CFP:
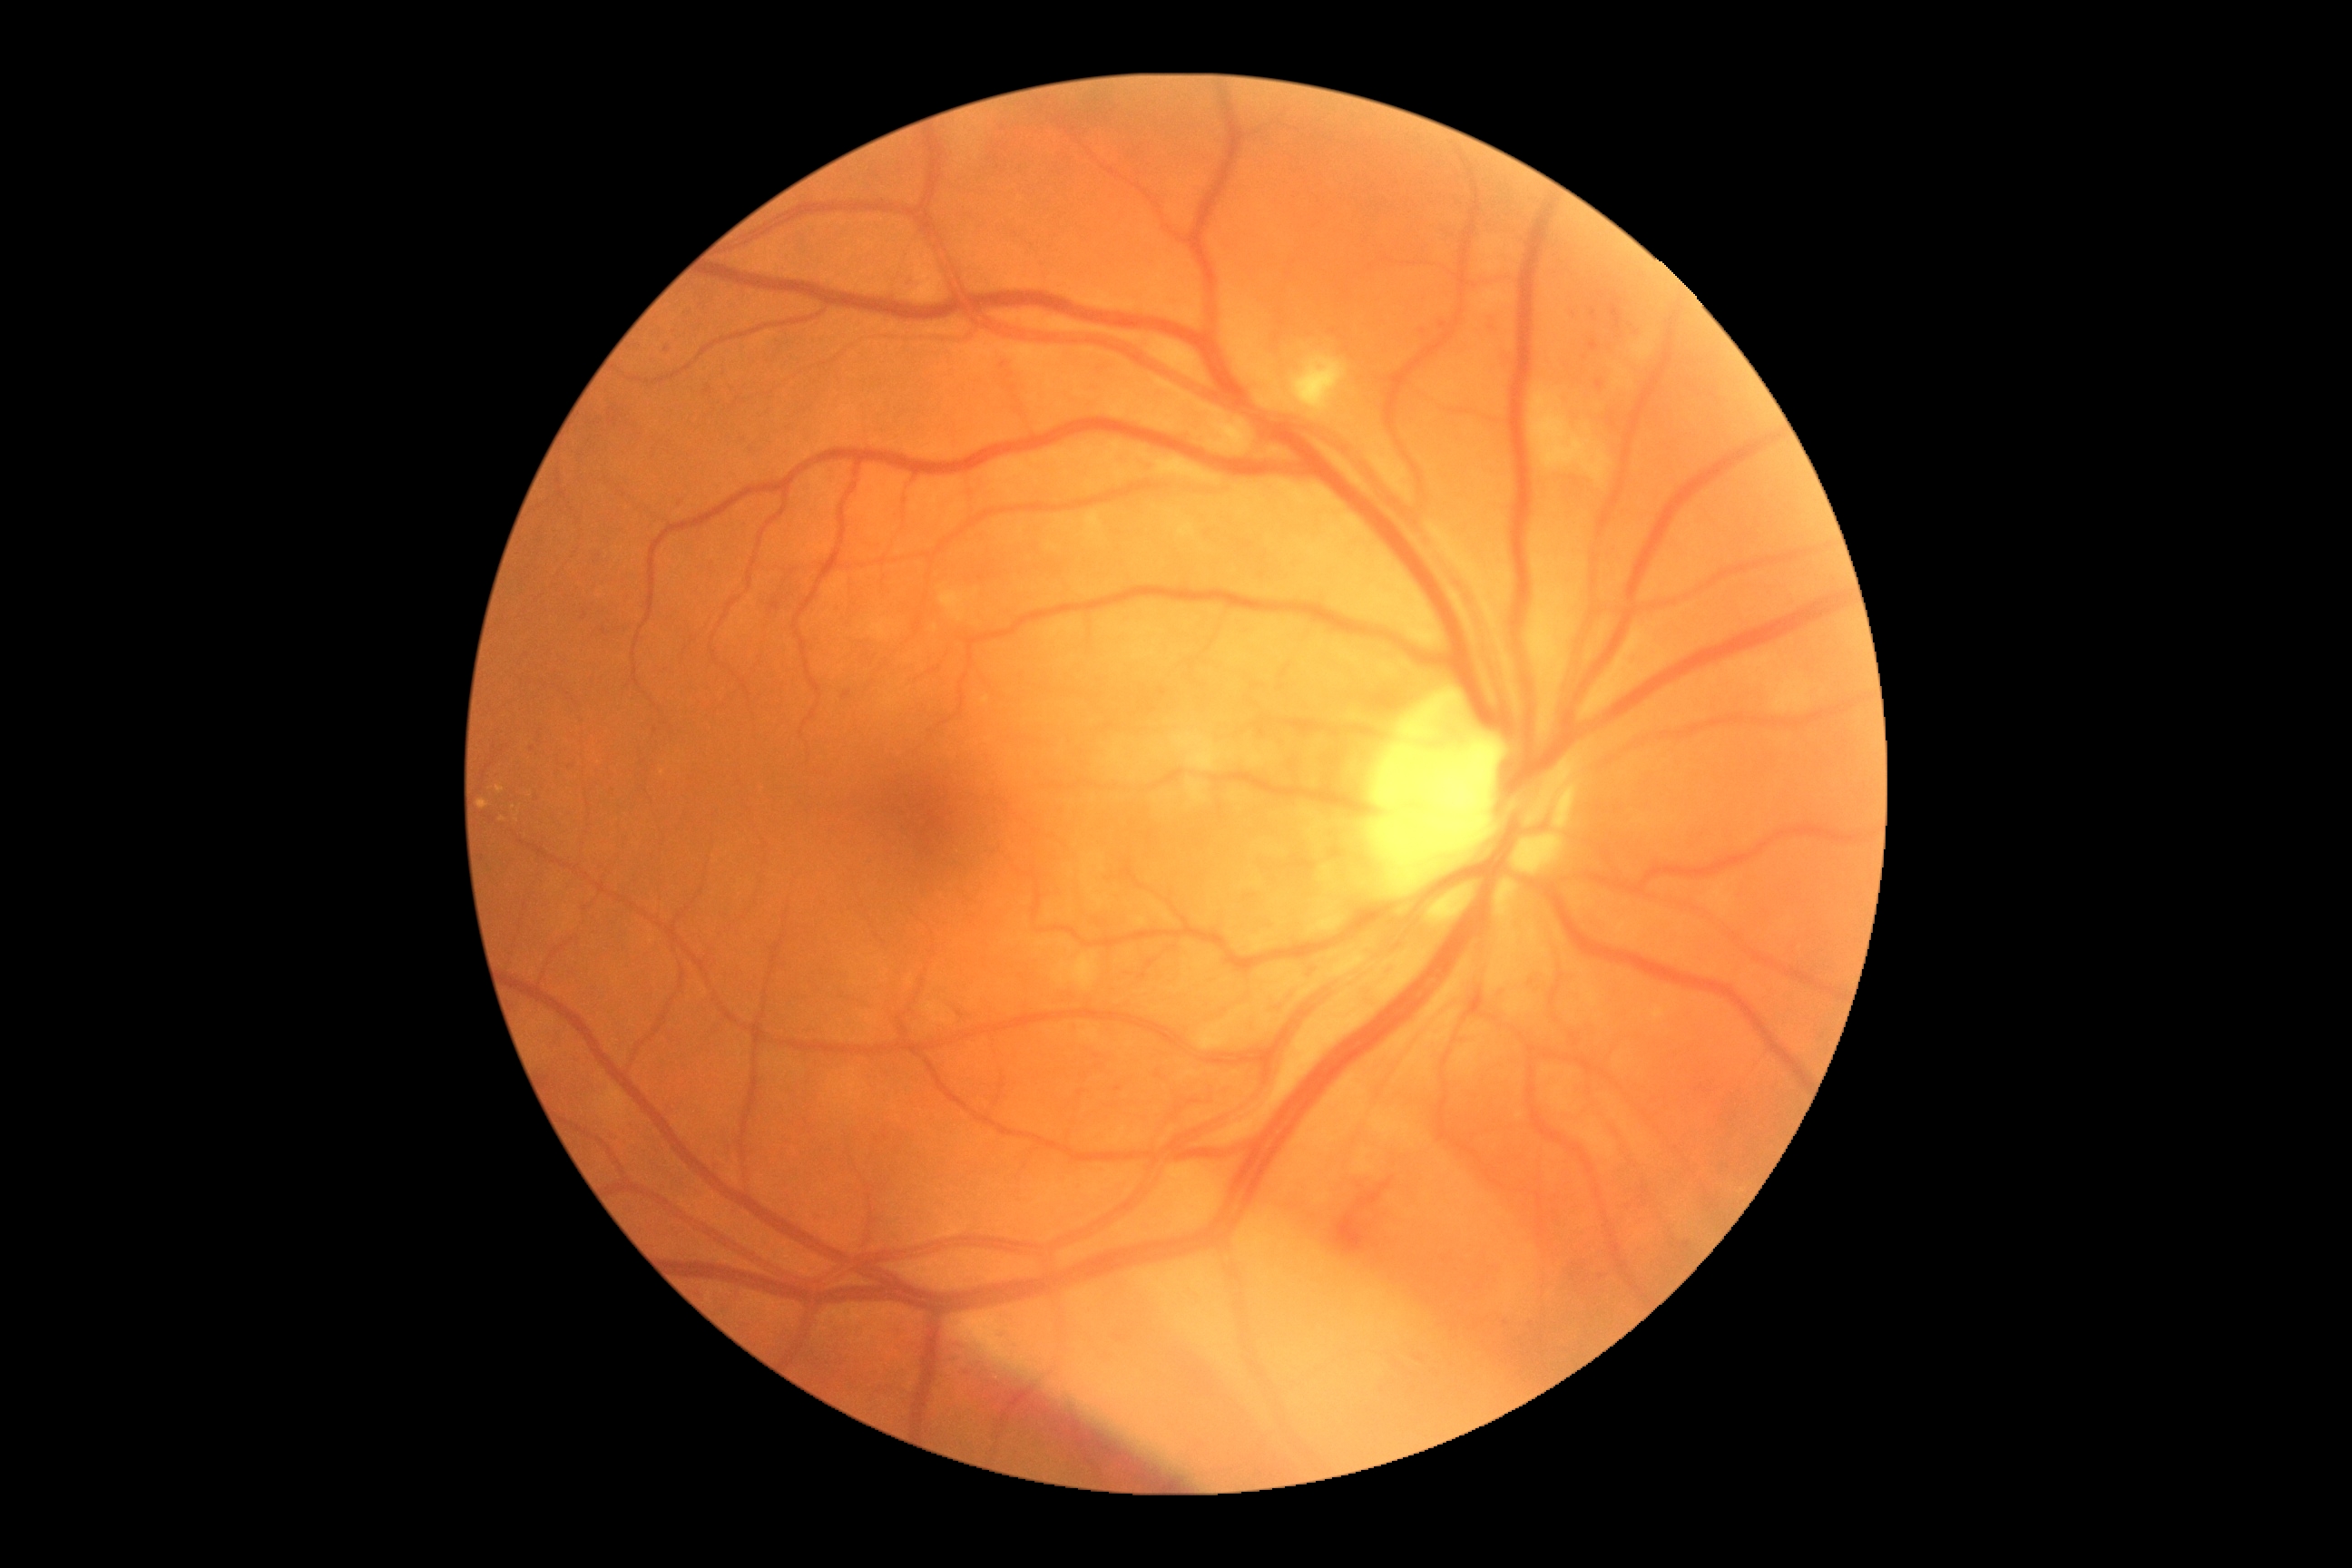

{"dr_category": "non-proliferative diabetic retinopathy", "dr_grade": "grade 2 (moderate NPDR) — more than just microaneurysms but less than severe NPDR"}